Color fundus image, field includes the optic disc and macula:
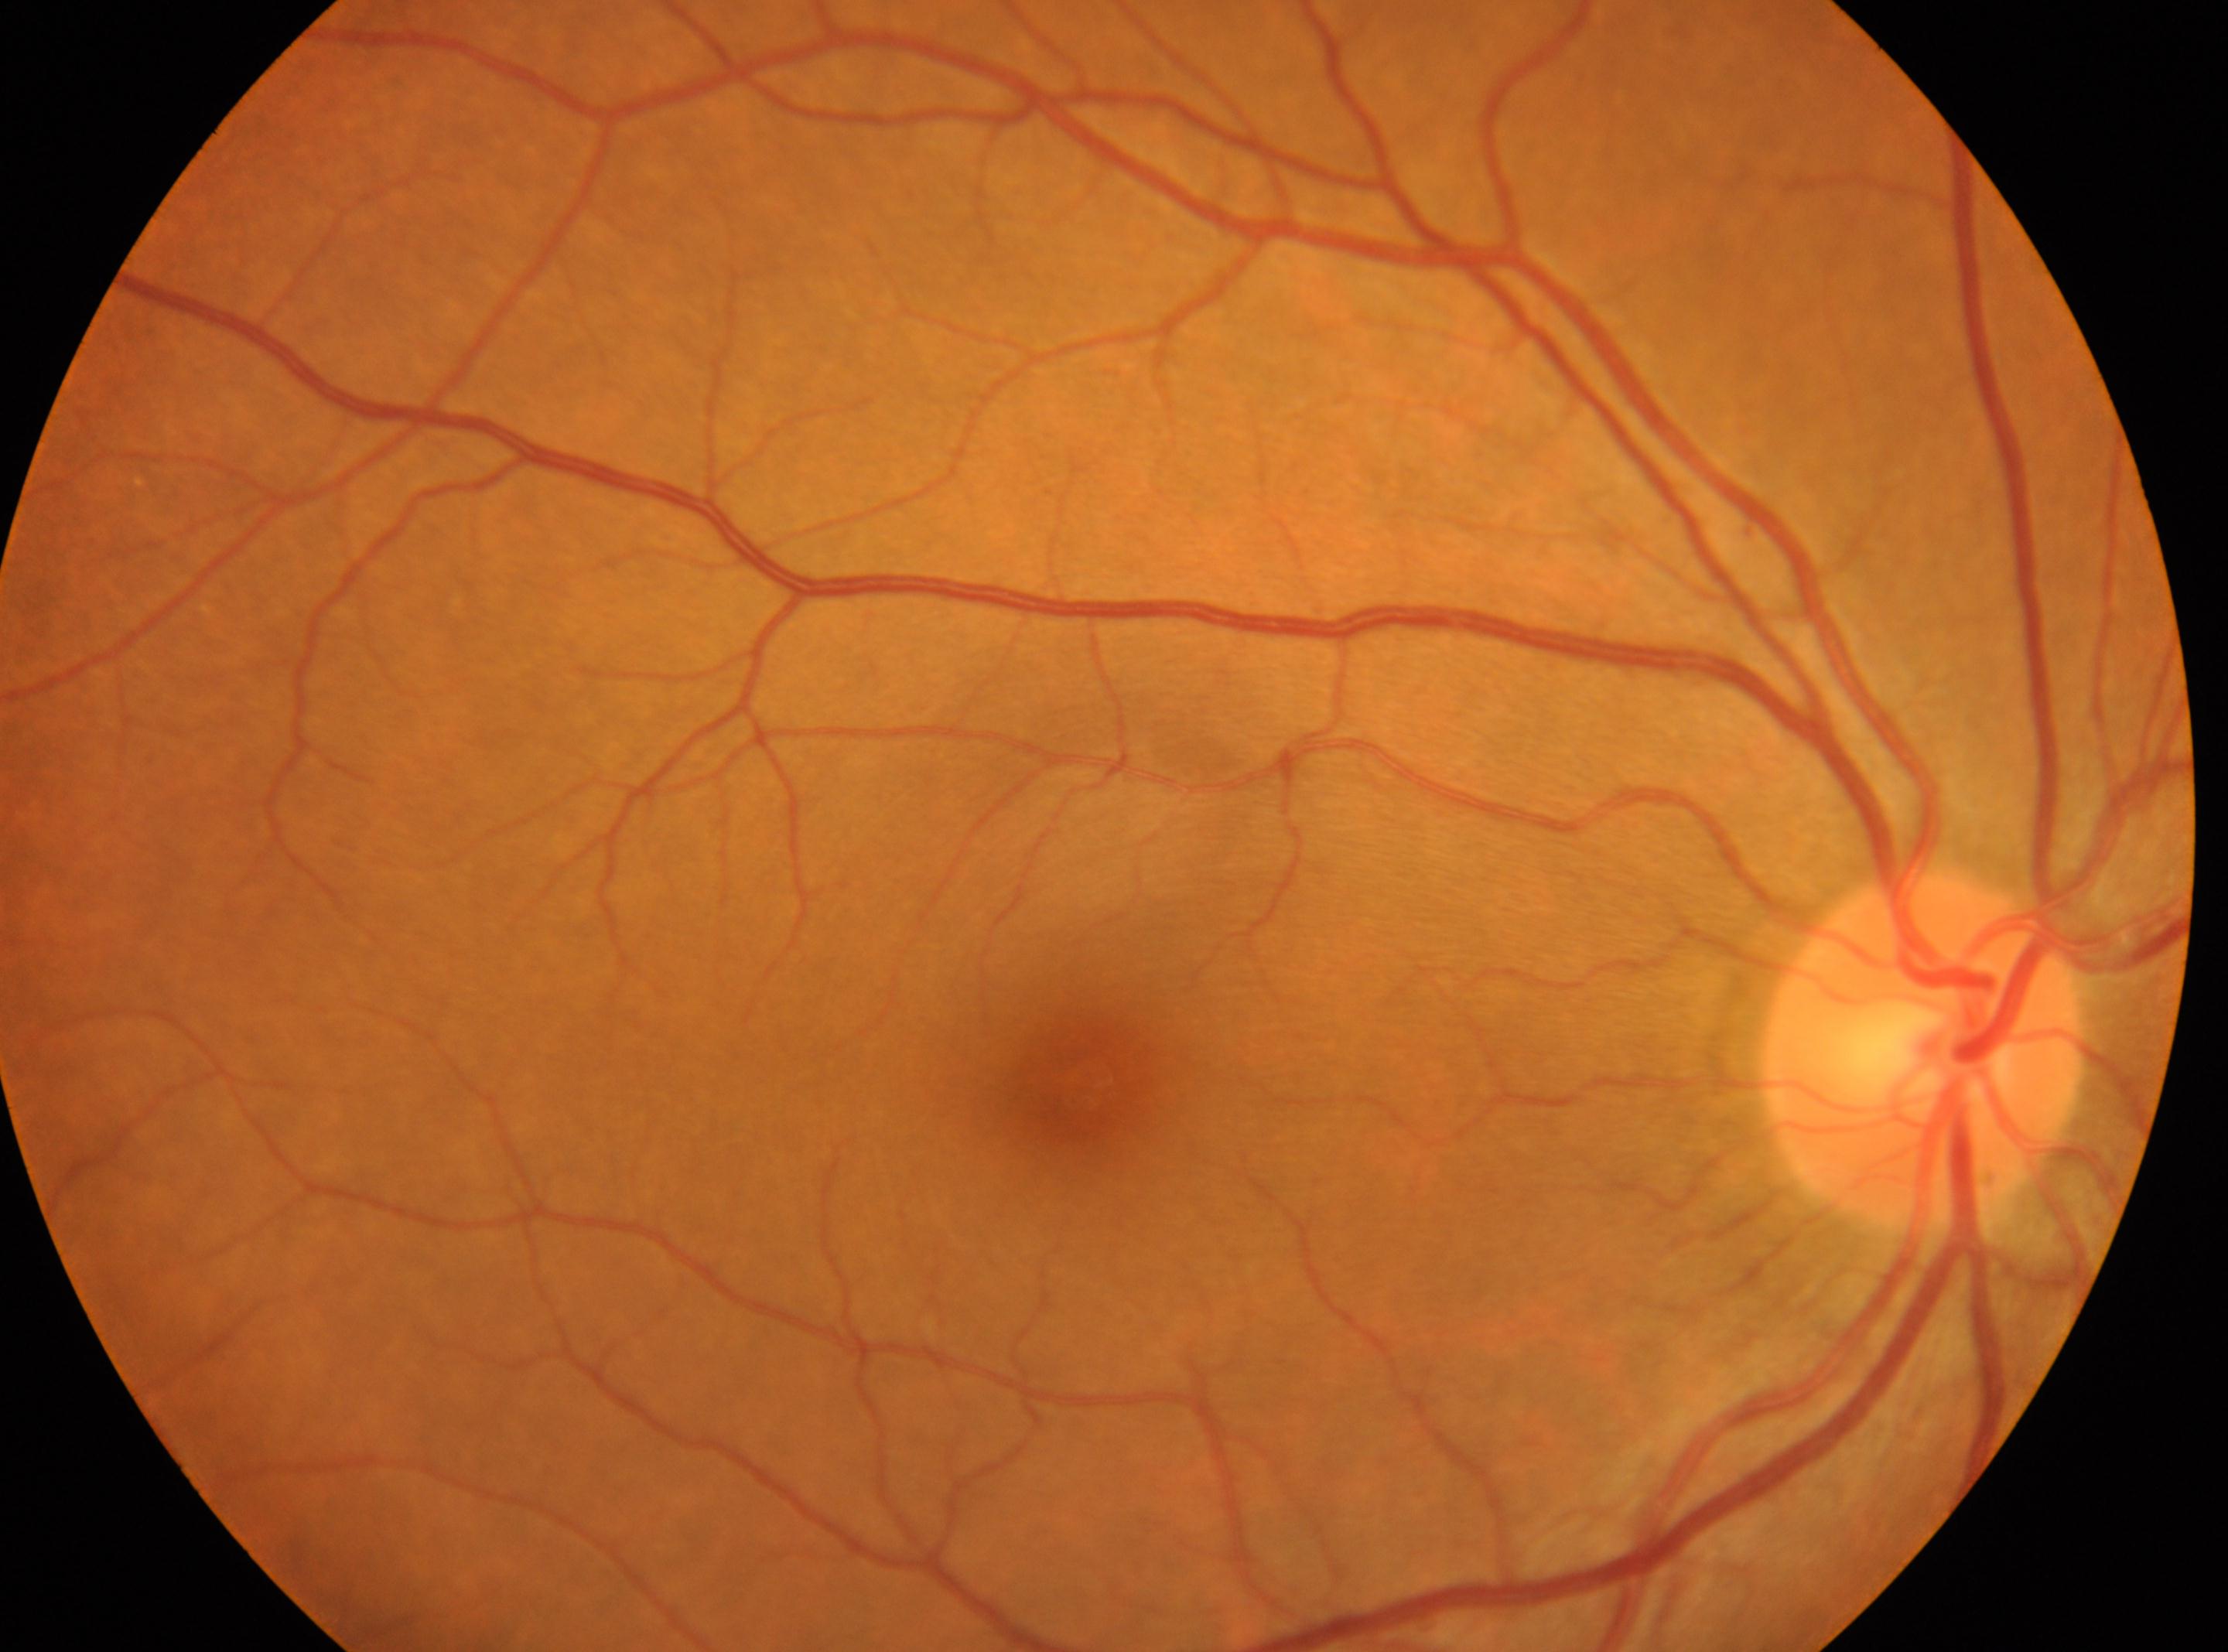
The optic disc is at 1922px, 1046px. Fovea: 1082px, 1084px. No diabetic retinopathy identified. DR grade: no apparent retinopathy (0). Eye: right eye.